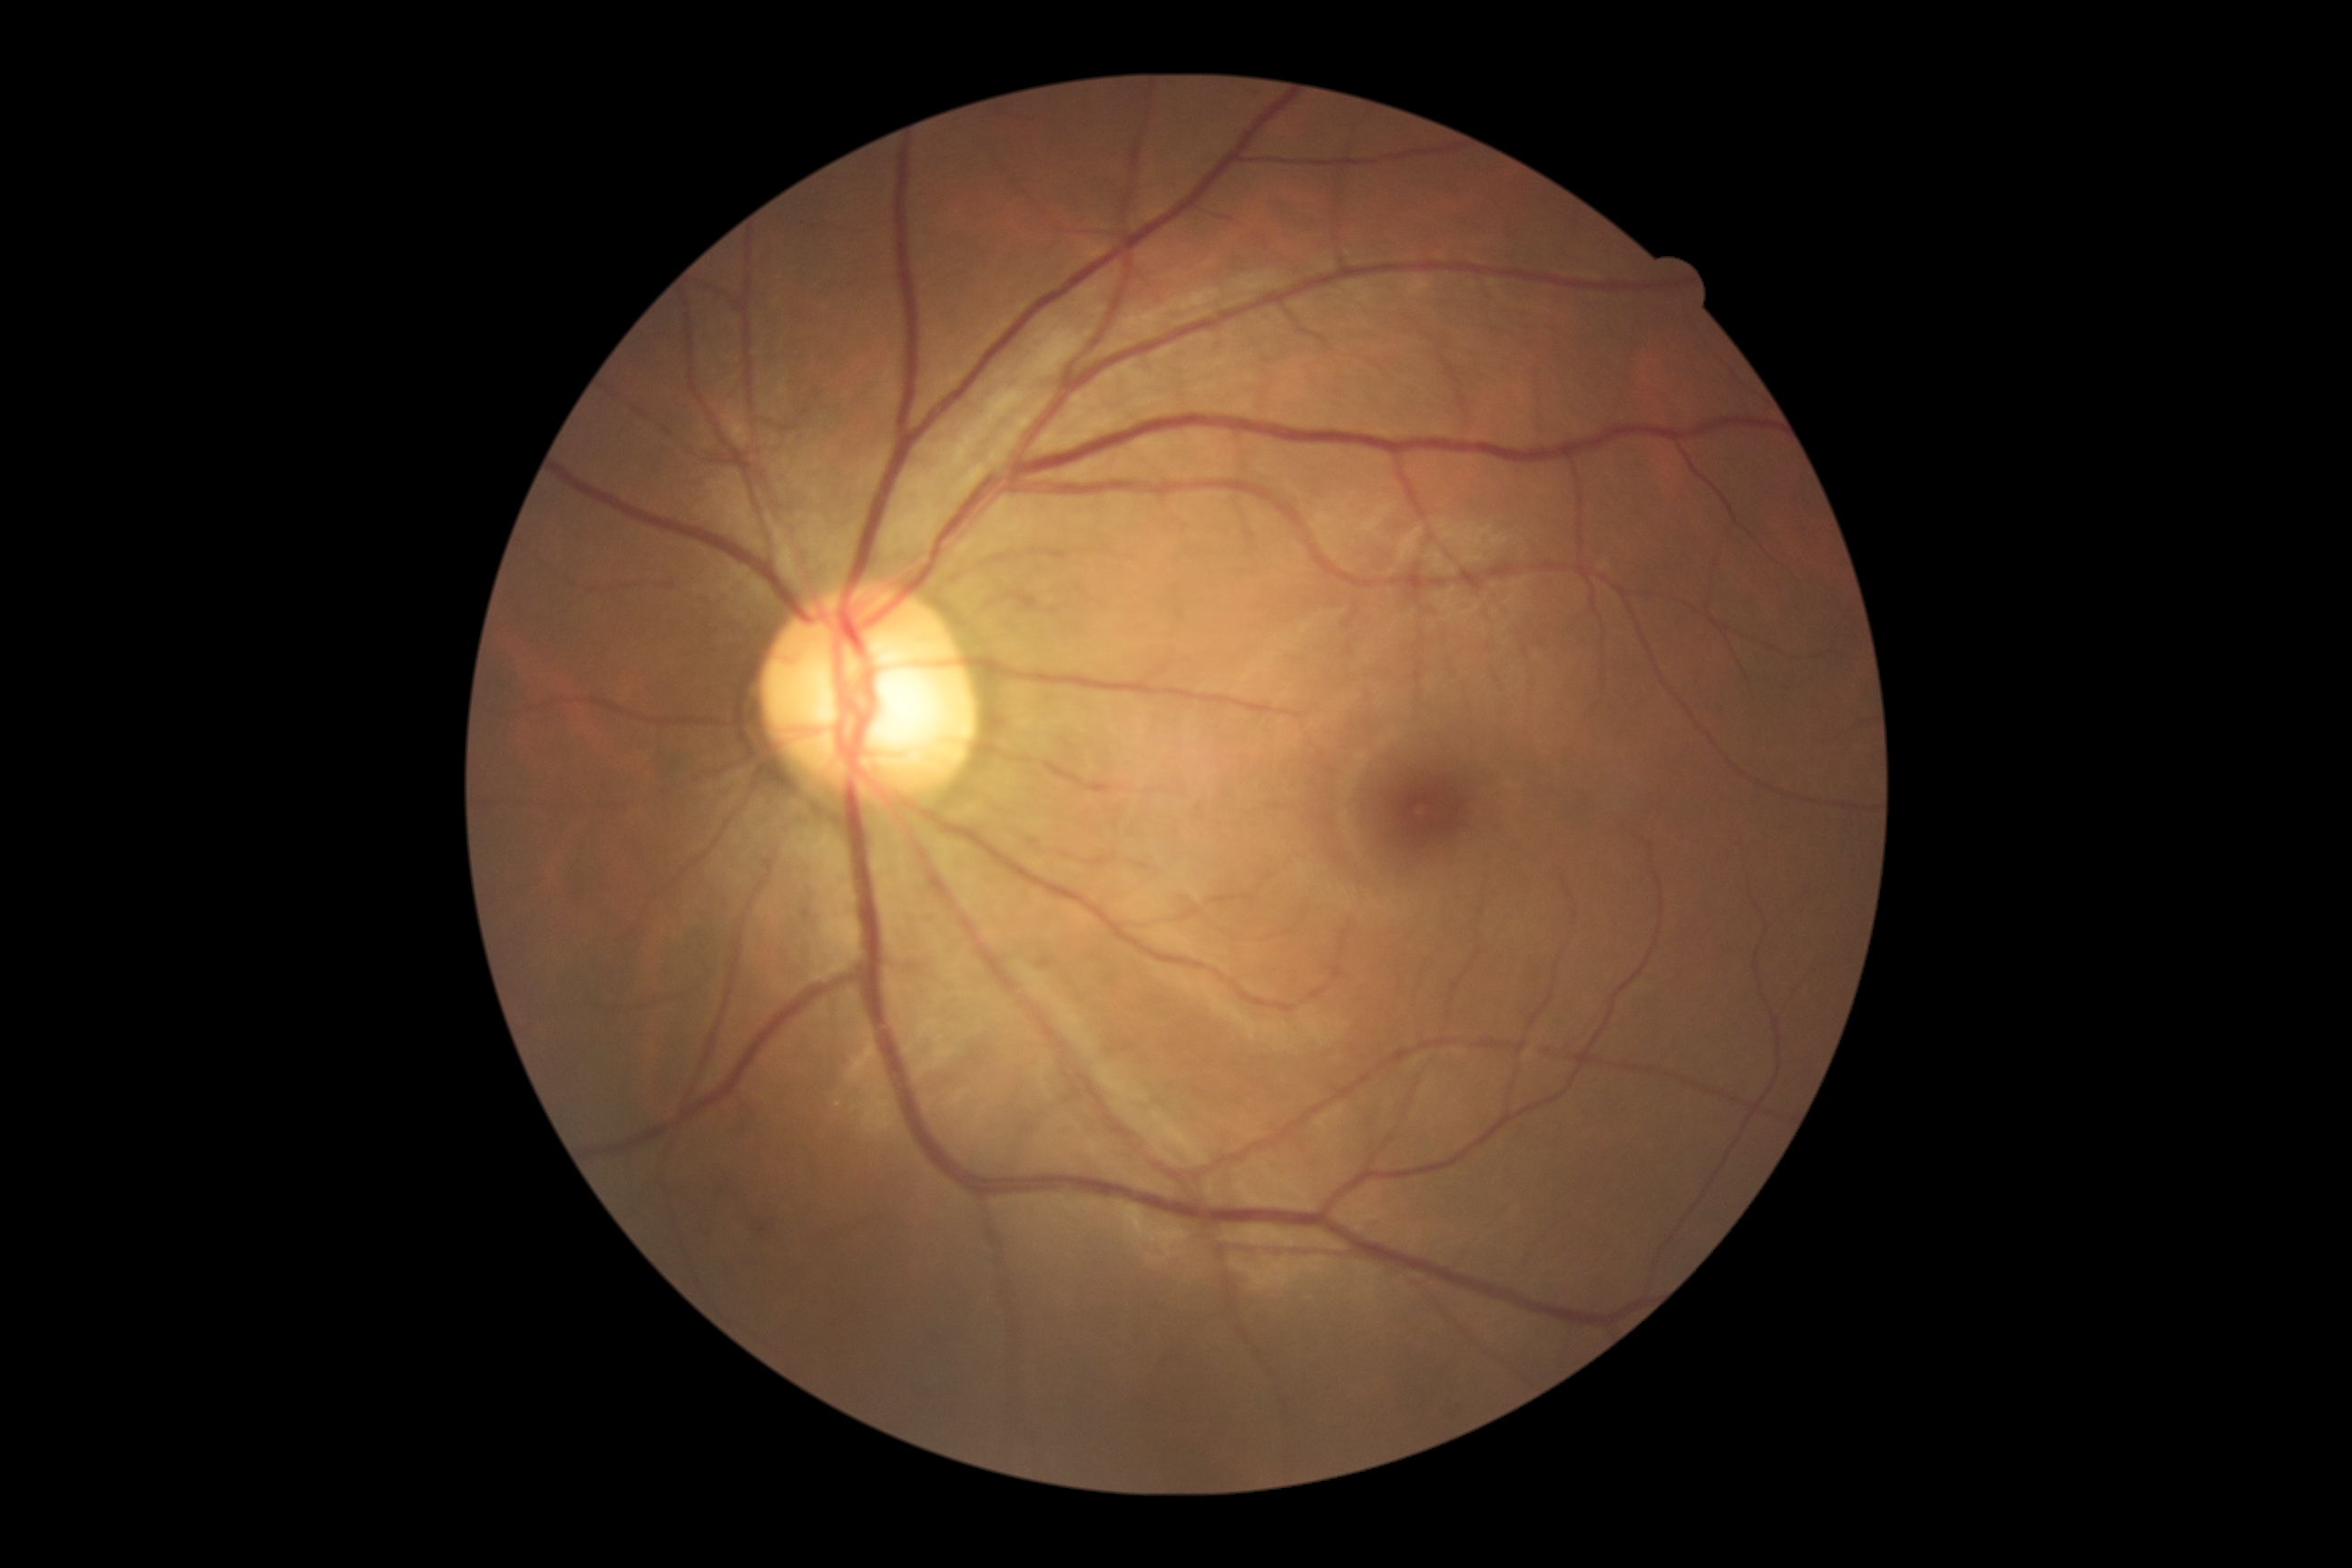 Diabetic retinopathy (DR): 2. Disease class: non-proliferative diabetic retinopathy.